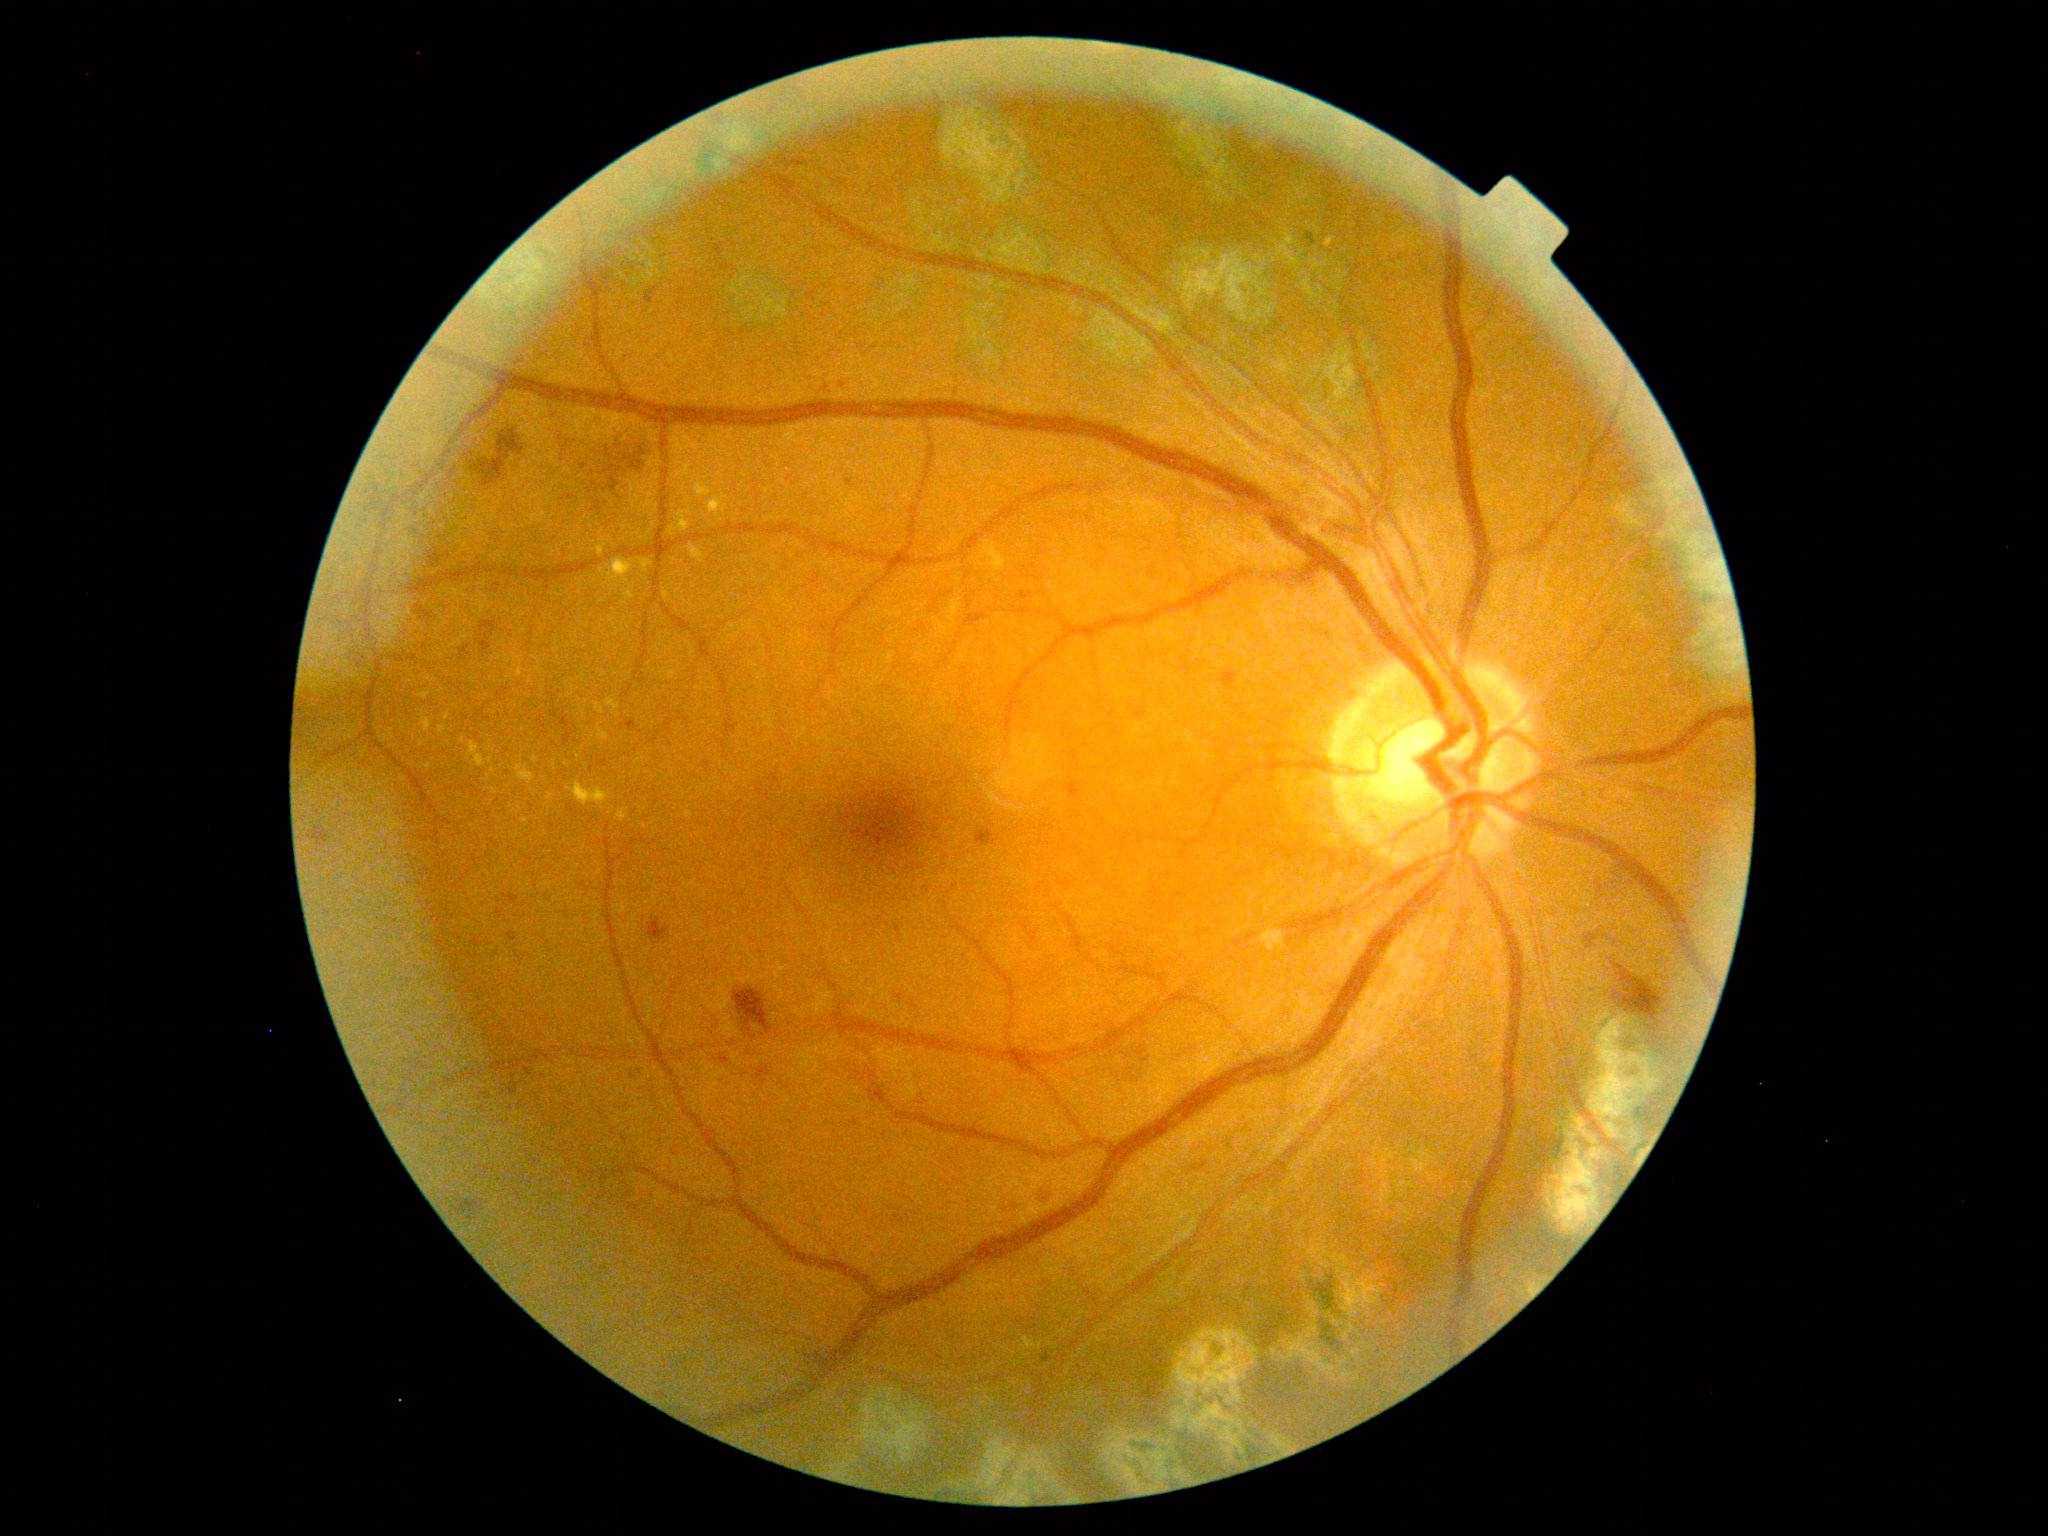
<lesions partial="true">
  <dr_grade>2</dr_grade>
  <ma partial="true">{"left": 509, "top": 1081, "right": 519, "bottom": 1095} | {"left": 1019, "top": 591, "right": 1033, "bottom": 601} | {"left": 504, "top": 894, "right": 520, "bottom": 903} | {"left": 706, "top": 761, "right": 711, "bottom": 773} | {"left": 622, "top": 354, "right": 631, "bottom": 363} | {"left": 629, "top": 1068, "right": 633, "bottom": 1079} | {"left": 525, "top": 1066, "right": 533, "bottom": 1076} | {"left": 509, "top": 932, "right": 517, "bottom": 942}</ma>
  <ma_small_approx>[850, 482] | [900, 997]</ma_small_approx>
  <se />
  <he partial="true">{"left": 1042, "top": 1191, "right": 1050, "bottom": 1199} | {"left": 460, "top": 645, "right": 470, "bottom": 660} | {"left": 429, "top": 548, "right": 451, "bottom": 568} | {"left": 757, "top": 1066, "right": 771, "bottom": 1079} | {"left": 977, "top": 827, "right": 1000, "bottom": 847} | {"left": 769, "top": 774, "right": 785, "bottom": 793} | {"left": 605, "top": 465, "right": 616, "bottom": 474} | {"left": 1612, "top": 965, "right": 1666, "bottom": 1032} | {"left": 1066, "top": 783, "right": 1082, "bottom": 799} | {"left": 771, "top": 152, "right": 810, "bottom": 174} | {"left": 734, "top": 987, "right": 772, "bottom": 1033} | {"left": 480, "top": 621, "right": 497, "bottom": 635} | {"left": 625, "top": 720, "right": 638, "bottom": 733} | {"left": 456, "top": 1201, "right": 482, "bottom": 1215} | {"left": 609, "top": 478, "right": 619, "bottom": 492}</he>
  <he_small_approx>[487, 637] | [569, 498] | [595, 485] | [590, 492] | [604, 490]</he_small_approx>
  <ex partial="true">{"left": 668, "top": 509, "right": 694, "bottom": 537} | {"left": 692, "top": 479, "right": 712, "bottom": 498} | {"left": 1325, "top": 237, "right": 1337, "bottom": 247} | {"left": 599, "top": 558, "right": 653, "bottom": 590} | {"left": 467, "top": 741, "right": 494, "bottom": 768} | {"left": 706, "top": 491, "right": 728, "bottom": 522} | {"left": 566, "top": 781, "right": 612, "bottom": 807}</ex>
  <ex_small_approx>[691, 501] | [683, 488] | [716, 485] | [657, 507]</ex_small_approx>
</lesions>